45 degree fundus photograph, 848x848px: 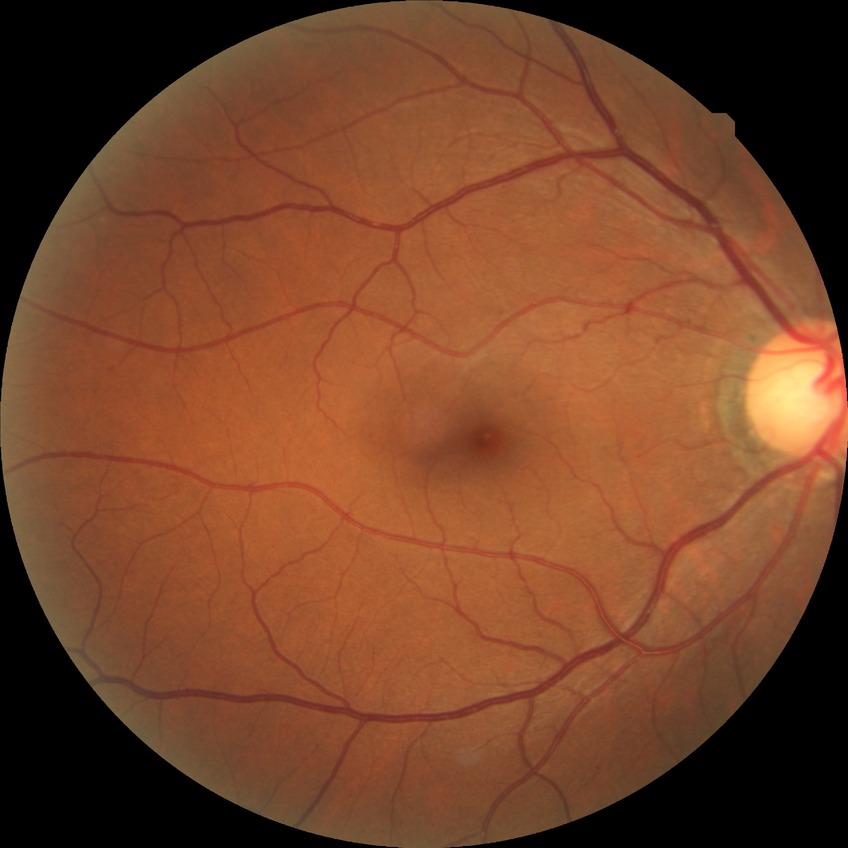

Diabetic retinopathy (DR) is no diabetic retinopathy (NDR).